Pediatric retinal photograph (wide-field) · 1240 by 1240 pixels — 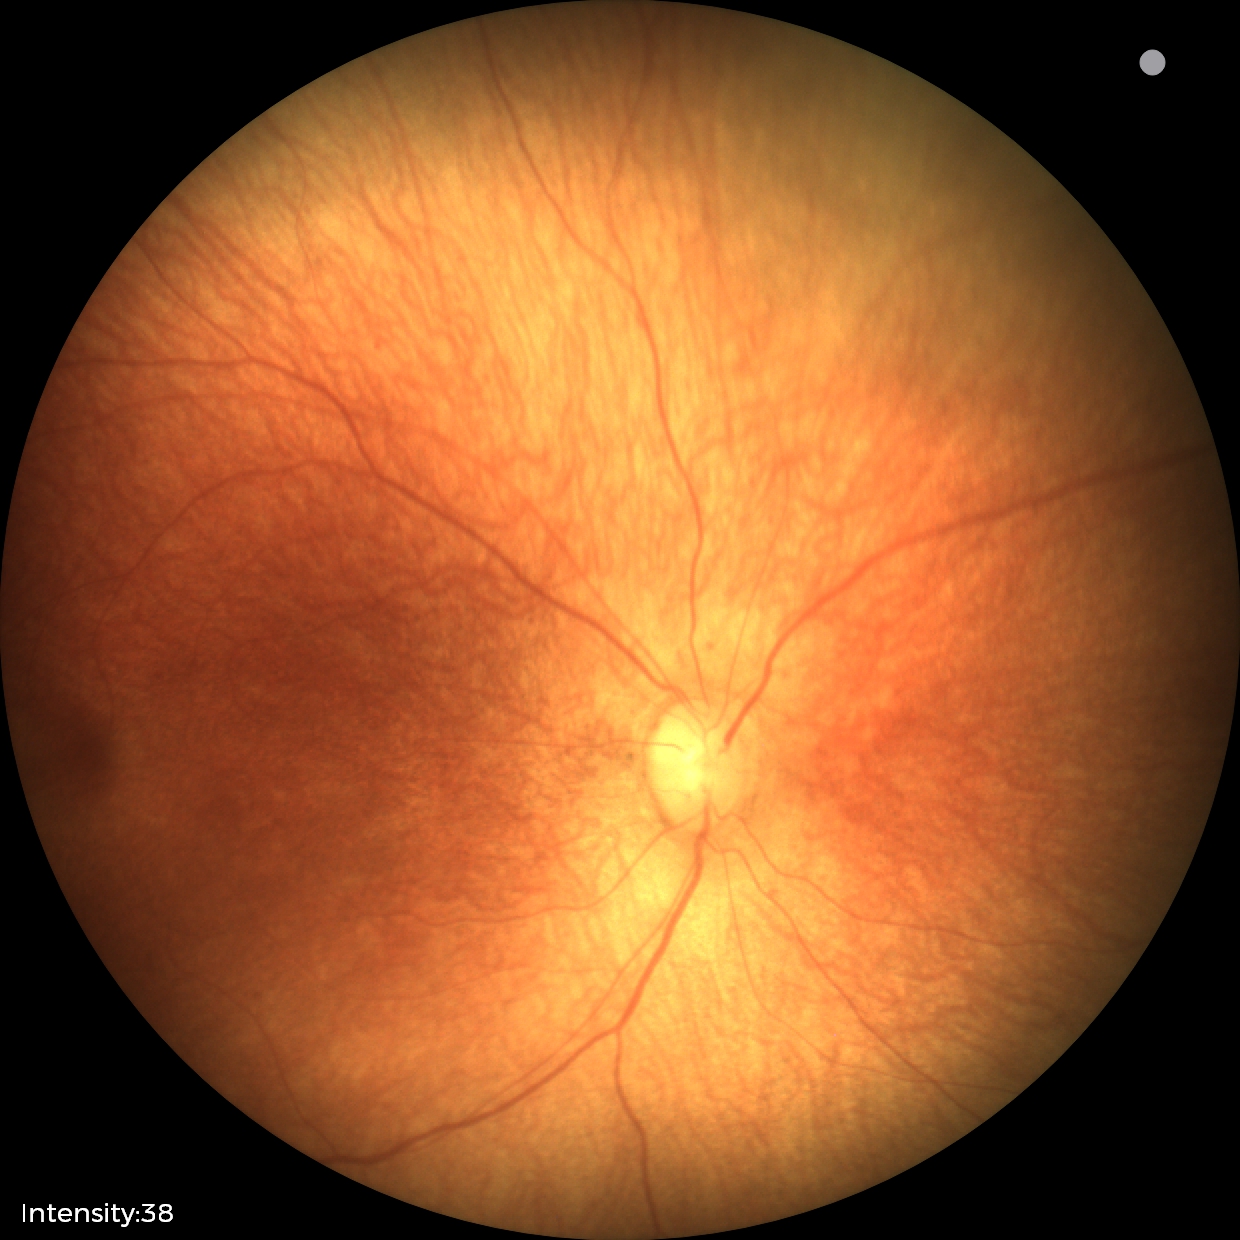 Normal screening examination.